Pediatric retinal photograph (wide-field) — 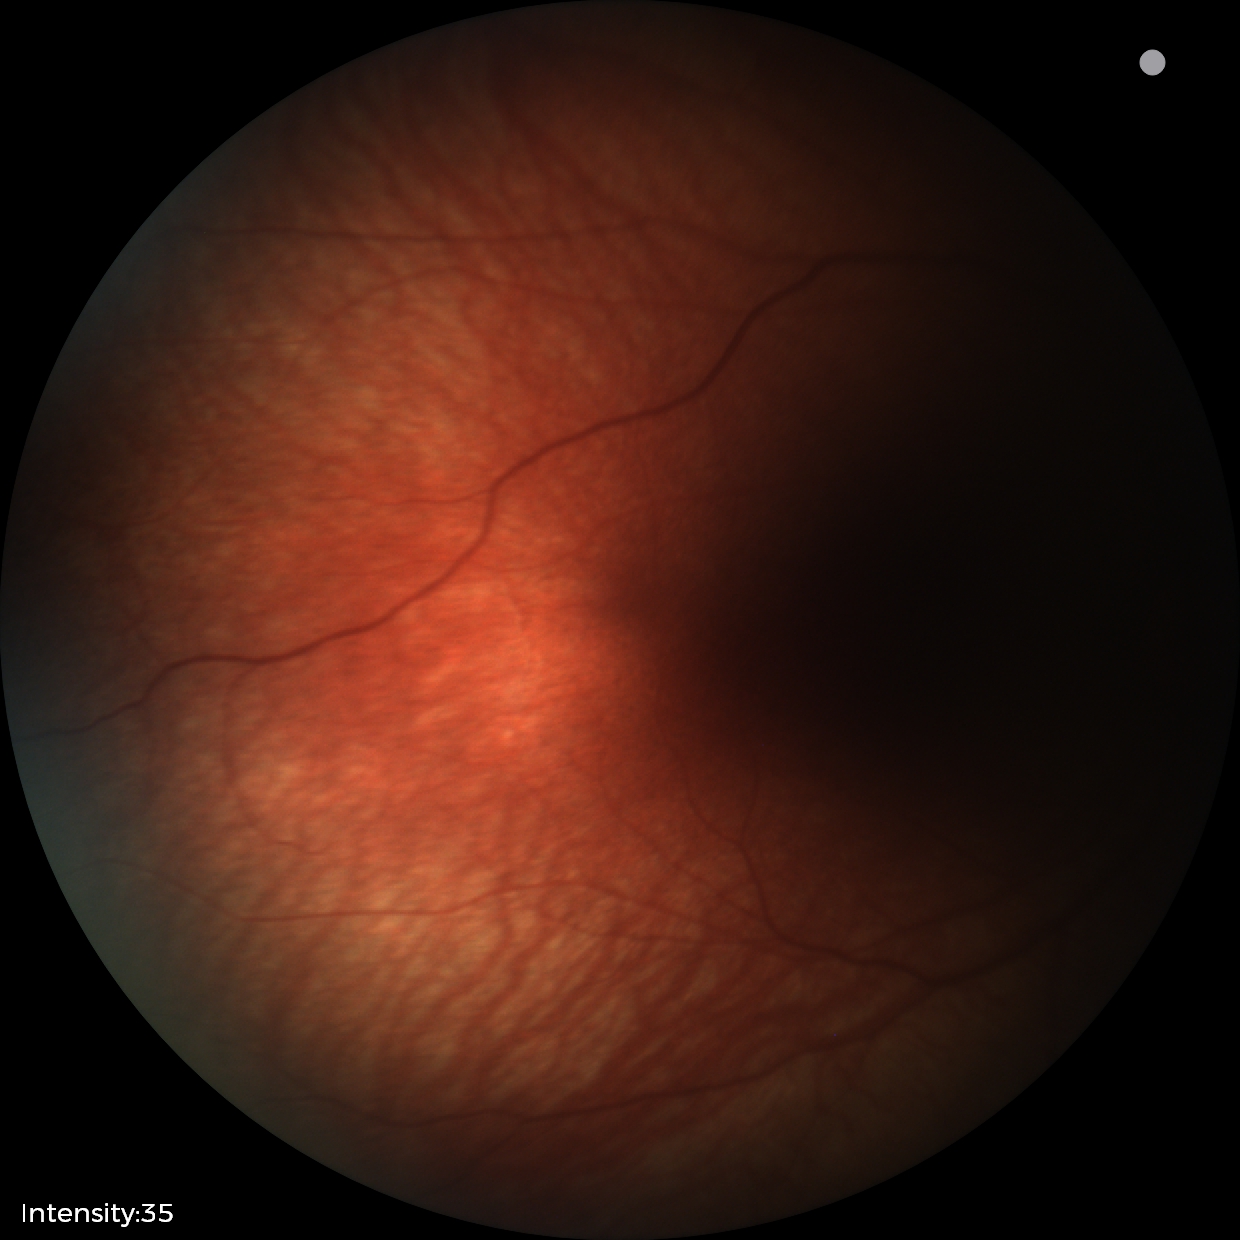
Screening: no abnormal retinal findings.